Color fundus image: 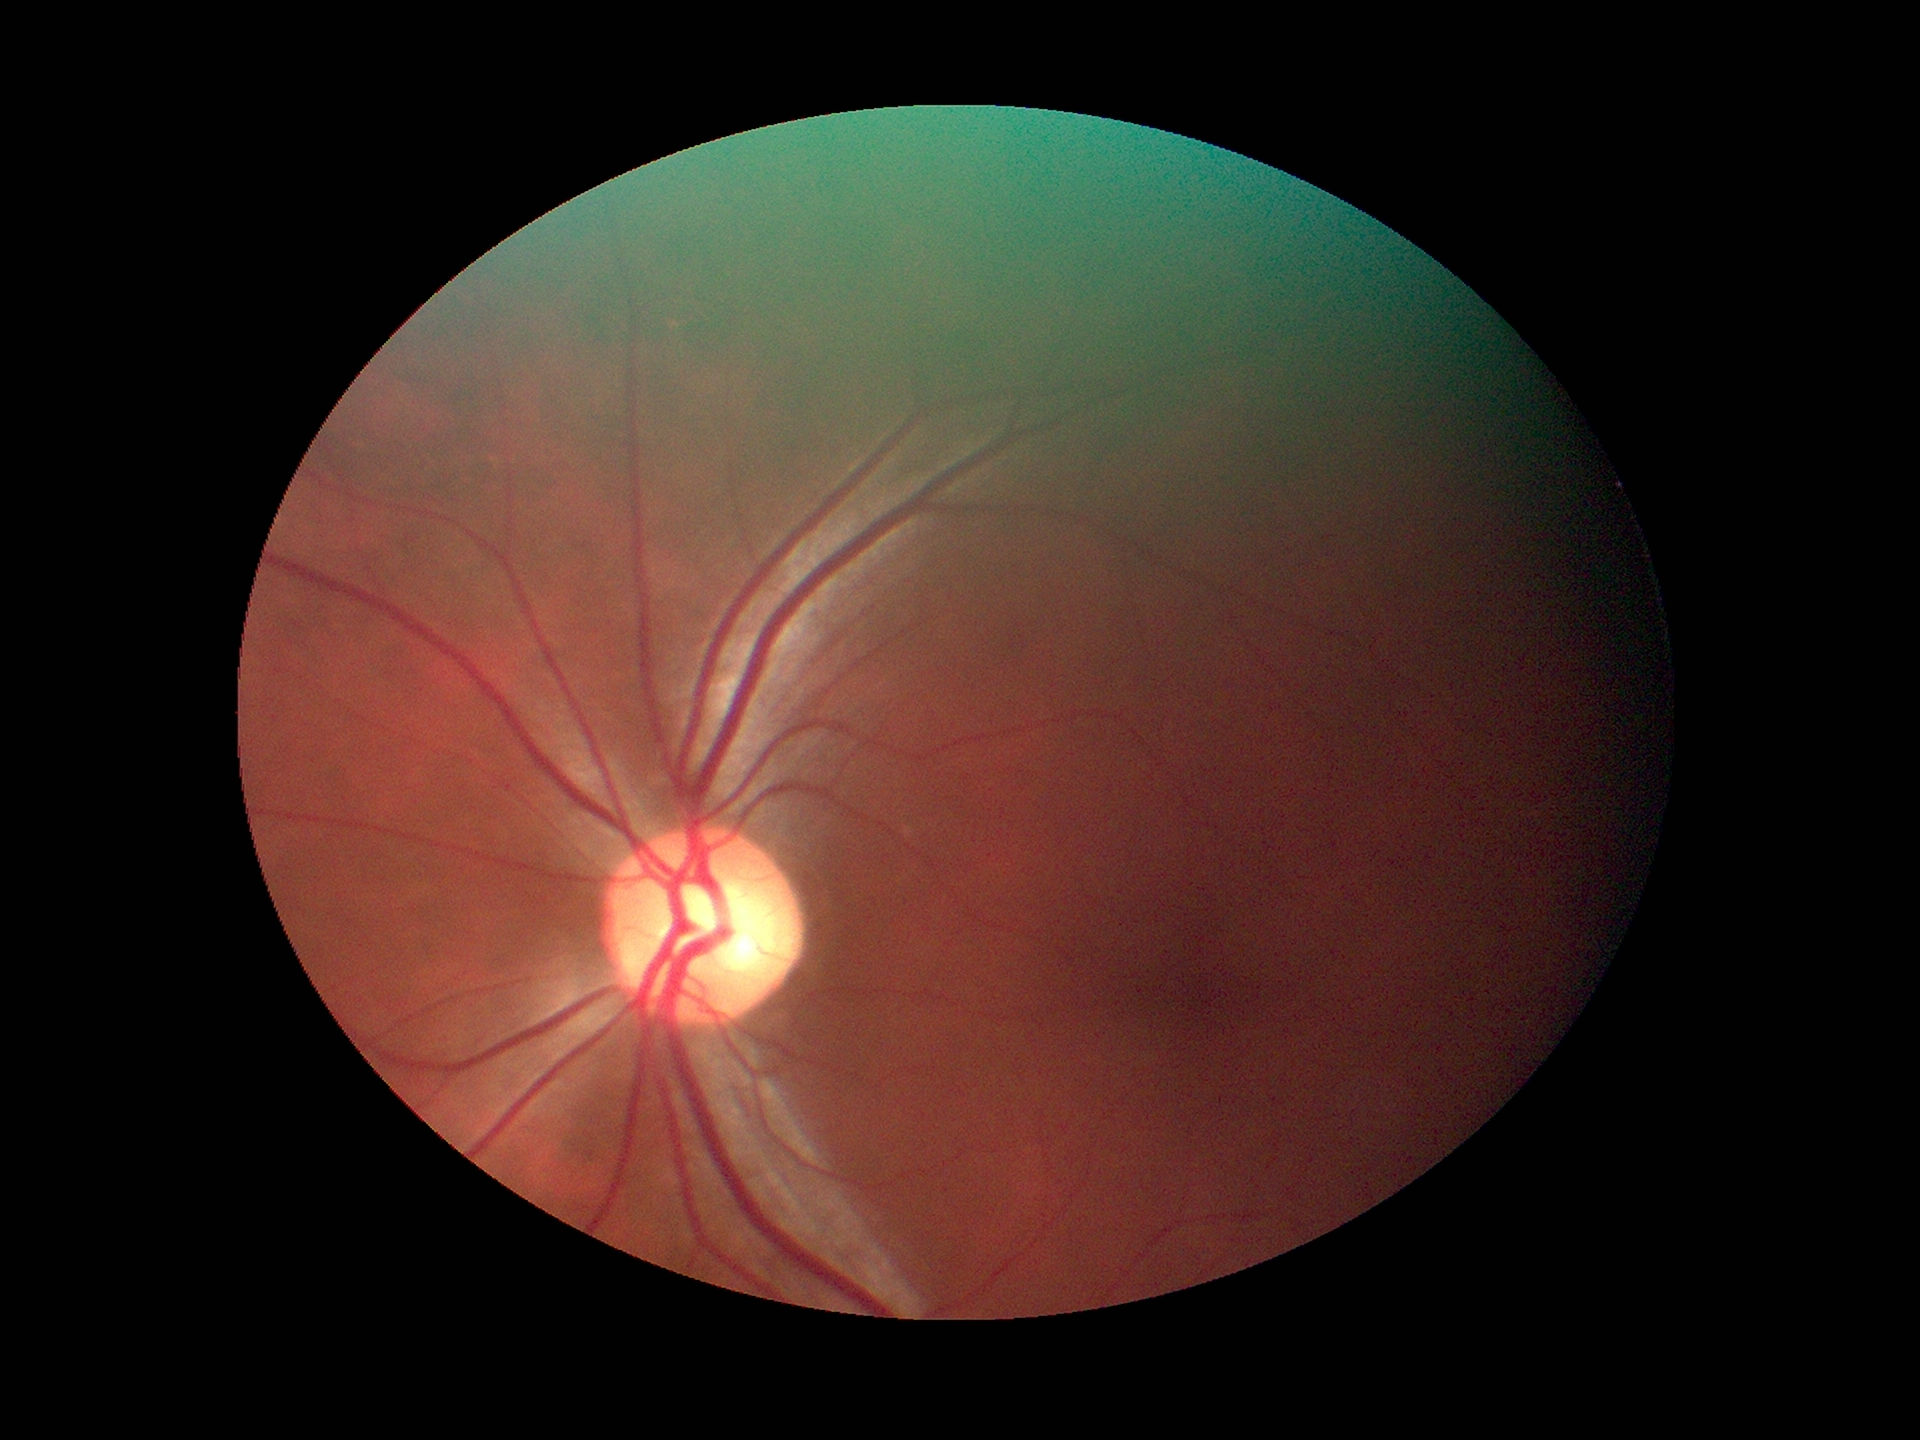
Vertical CDR (VCDR) is 0.58. Negative for glaucoma suspicion.